Without pupil dilation, graded on the modified Davis scale — 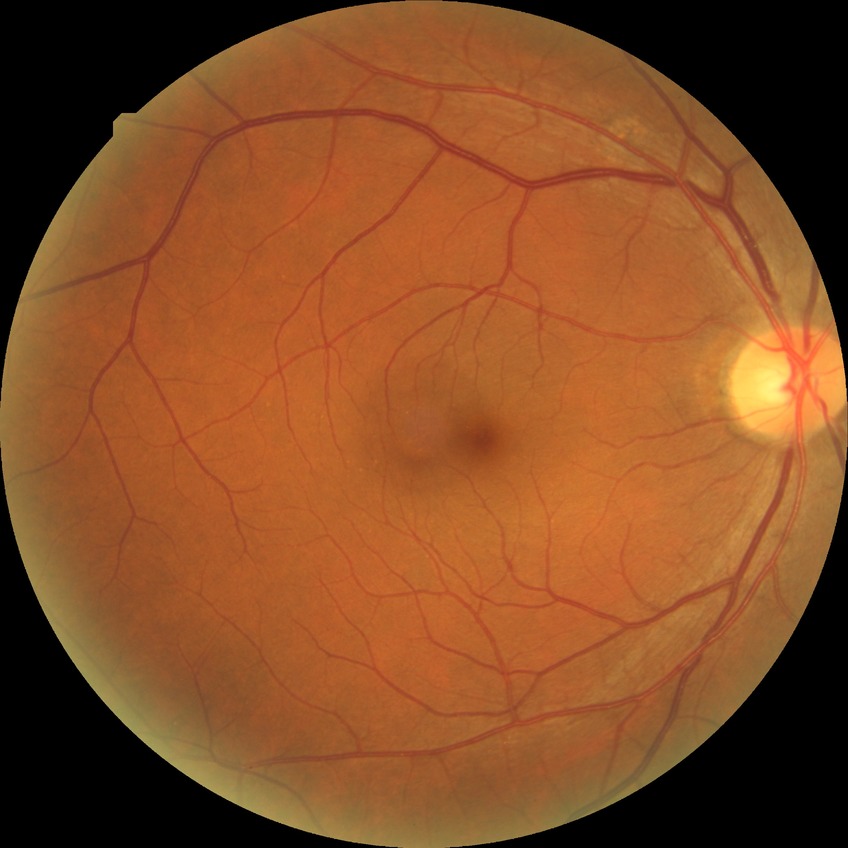 Modified Davis grade: NDR.